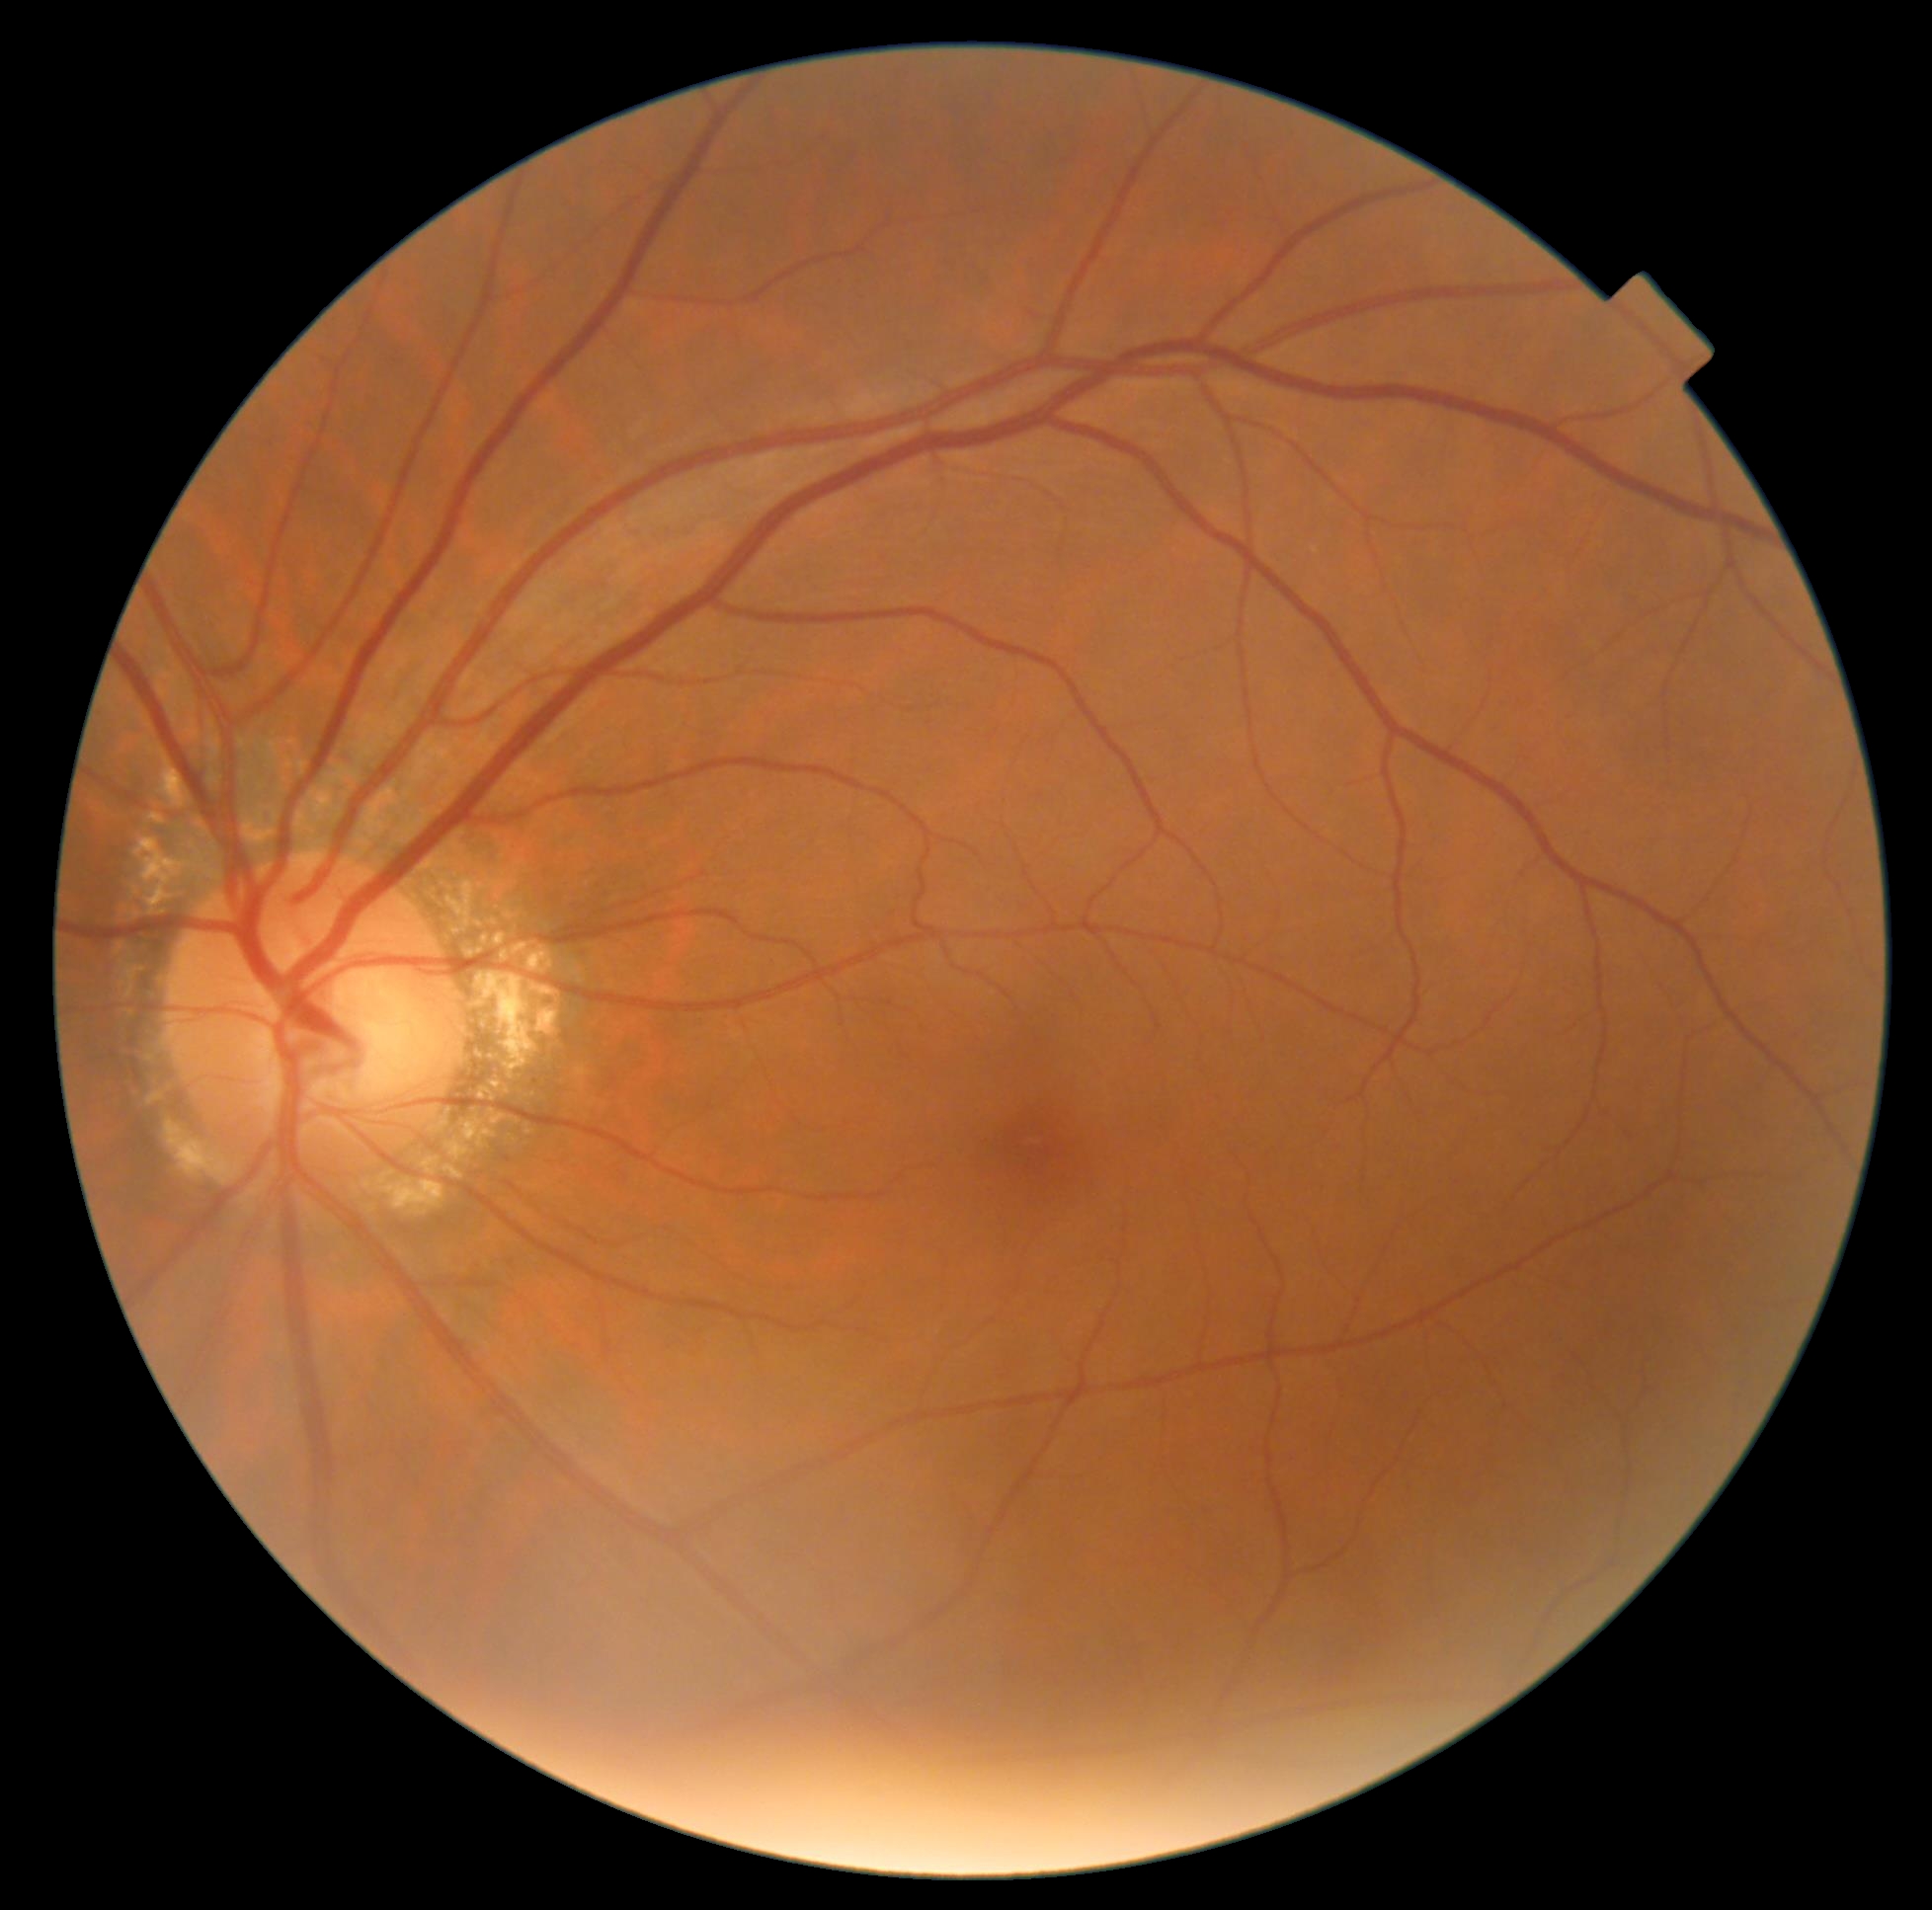
Diabetic retinopathy (DR): grade 0 (no apparent retinopathy).